2212 x 1659 pixels — 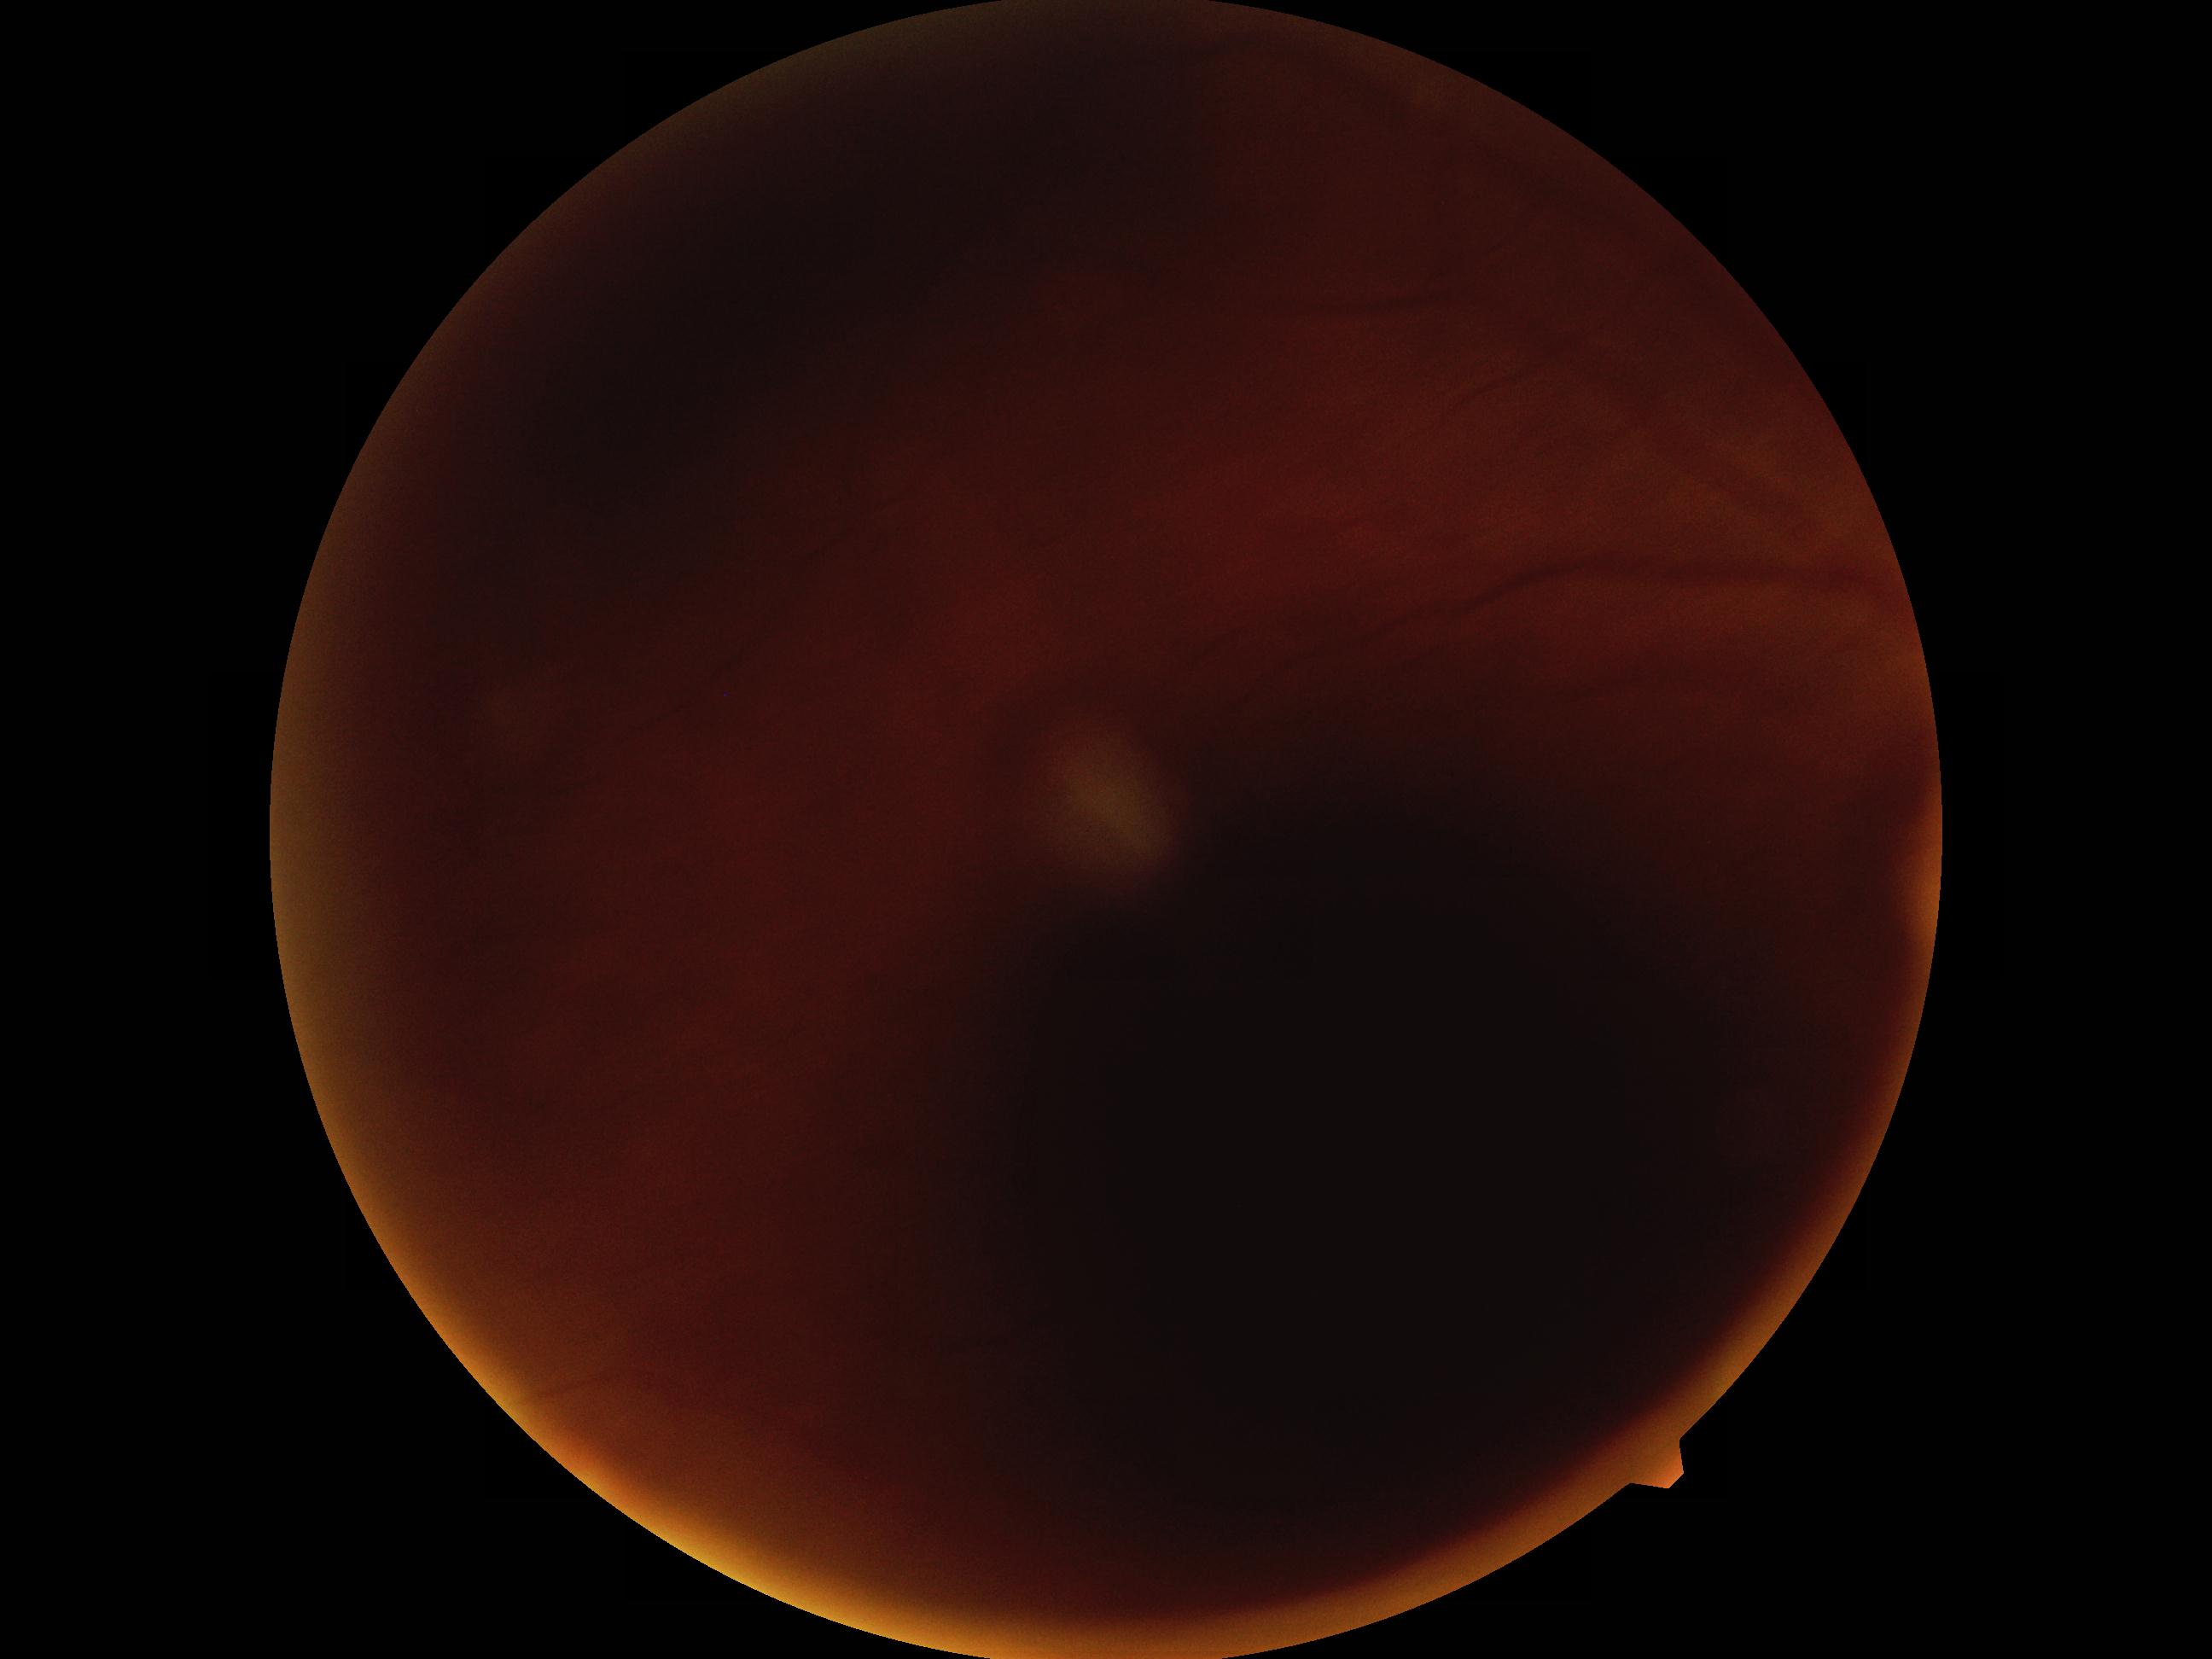 Annotations:
• DR stage — ungradable
• image quality — too poor for DR grading